Clarity RetCam 3, 130° FOV · wide-field fundus photograph from neonatal ROP screening: 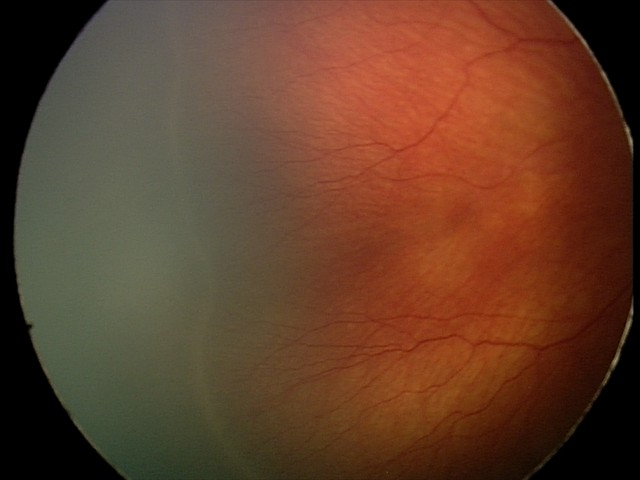 Diagnosis from this screening exam: retinopathy of prematurity stage 2.
No plus disease.